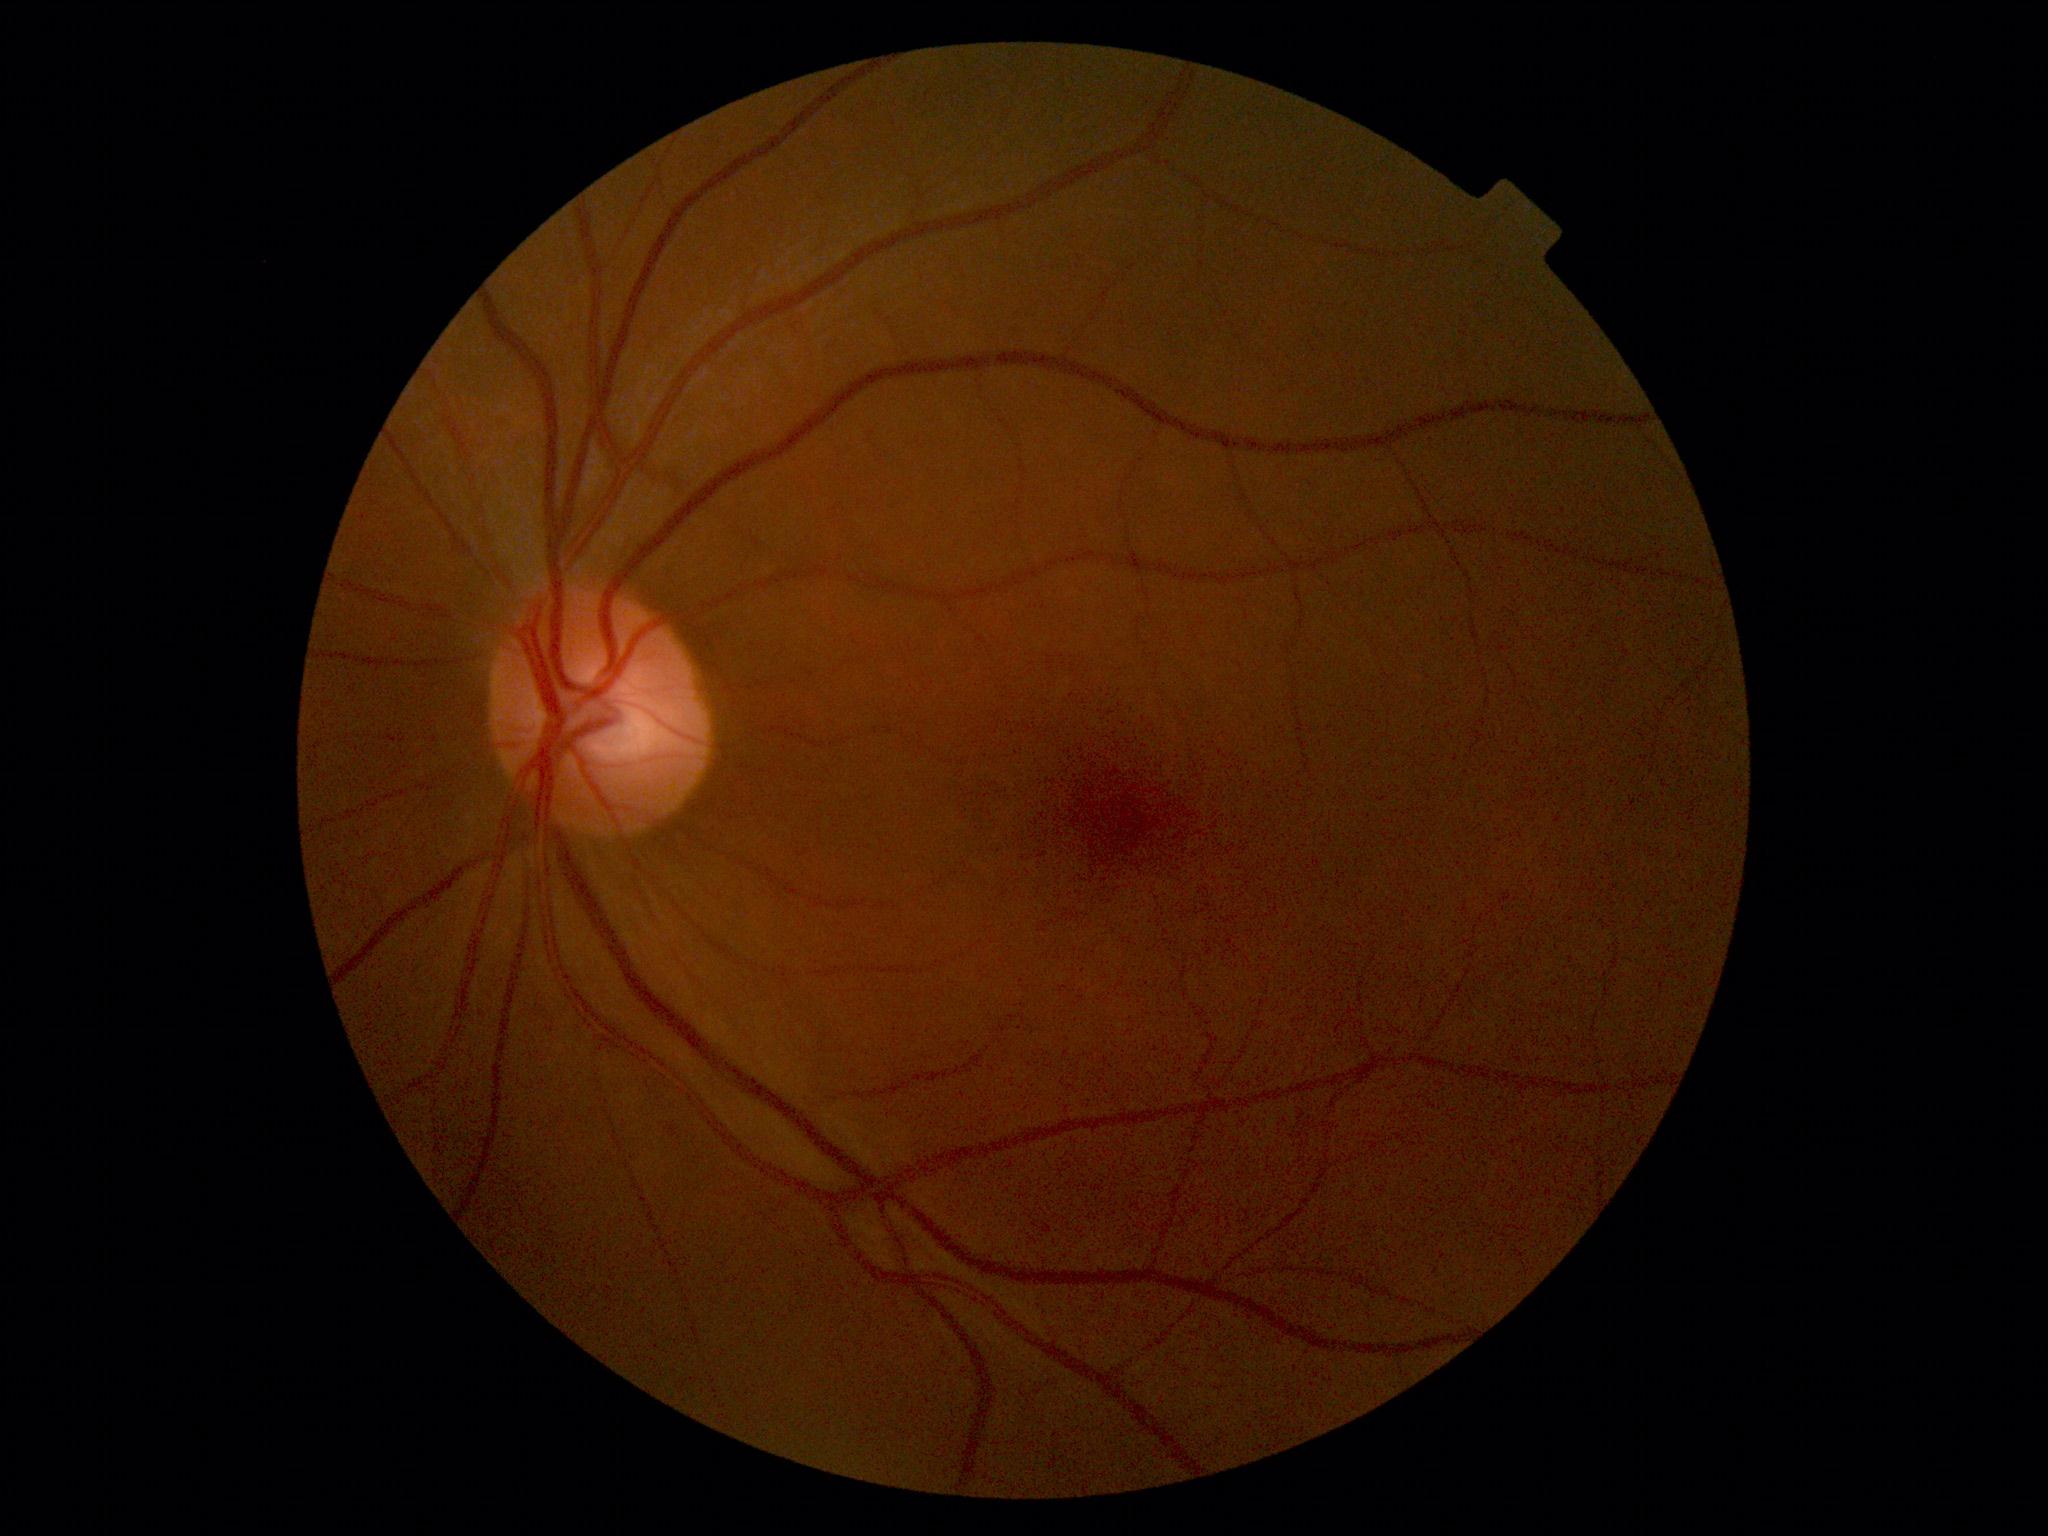
diabetic retinopathy grade: no apparent retinopathy (0).